No pharmacologic dilation. 848x848. Posterior pole color fundus photograph. Camera: NIDEK AFC-230. 45° field of view.
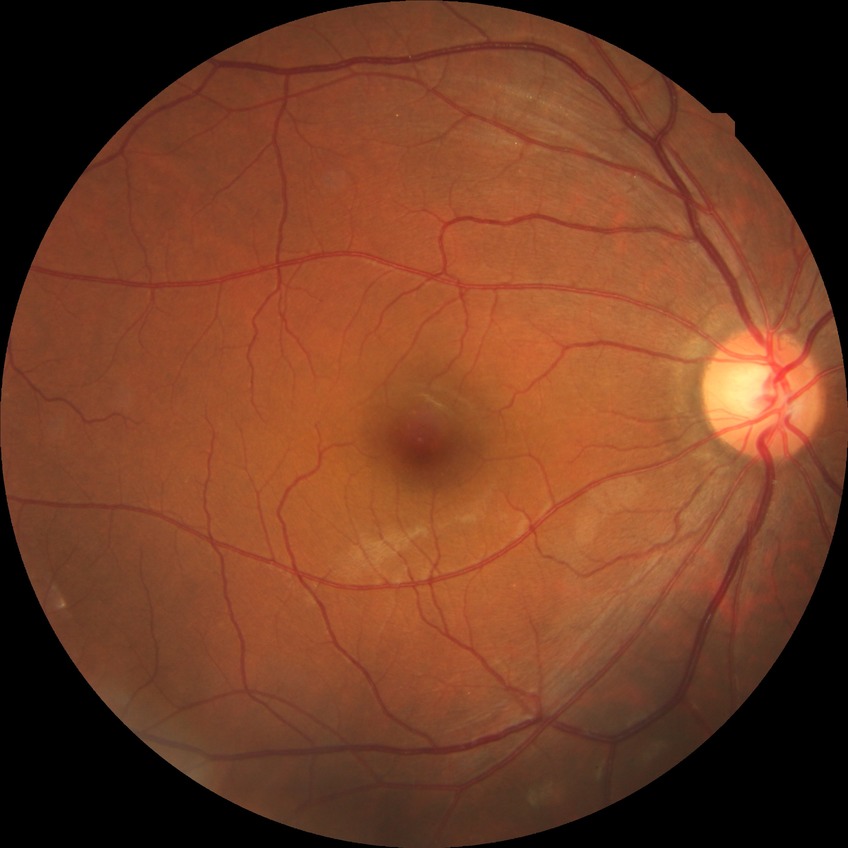 diabetic retinopathy (DR): NDR (no diabetic retinopathy).